Wide-field contact fundus photograph of an infant:
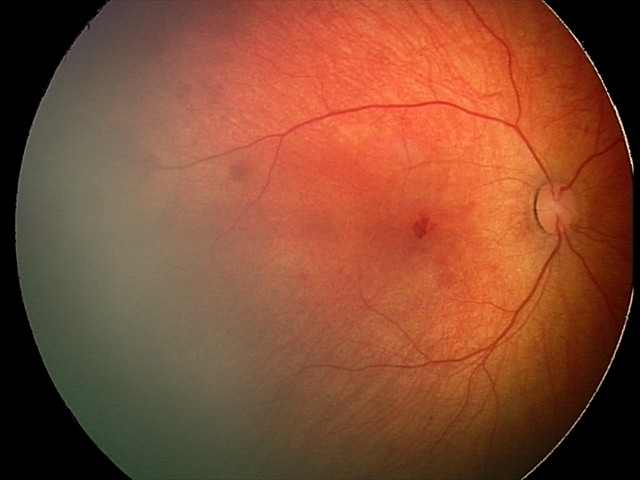 Screening examination consistent with retinal hemorrhages.